848 by 848 pixels · acquired with a NIDEK AFC-230.
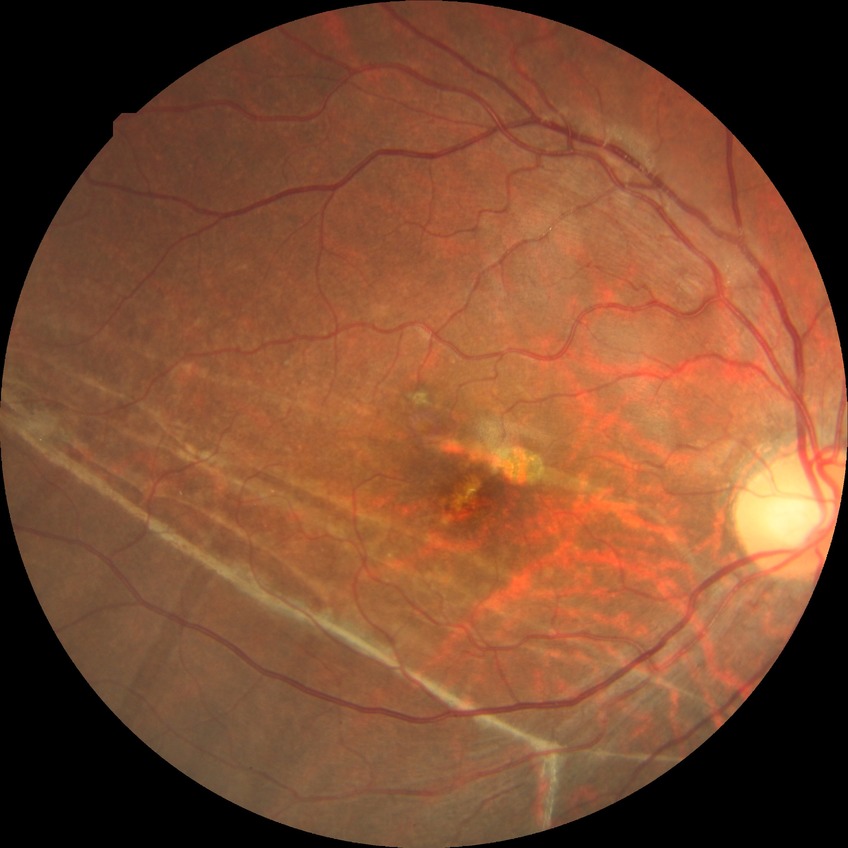

Diabetic retinopathy (DR): no diabetic retinopathy (NDR).